Camera: Natus RetCam Envision (130° FOV); wide-field fundus photograph of an infant.
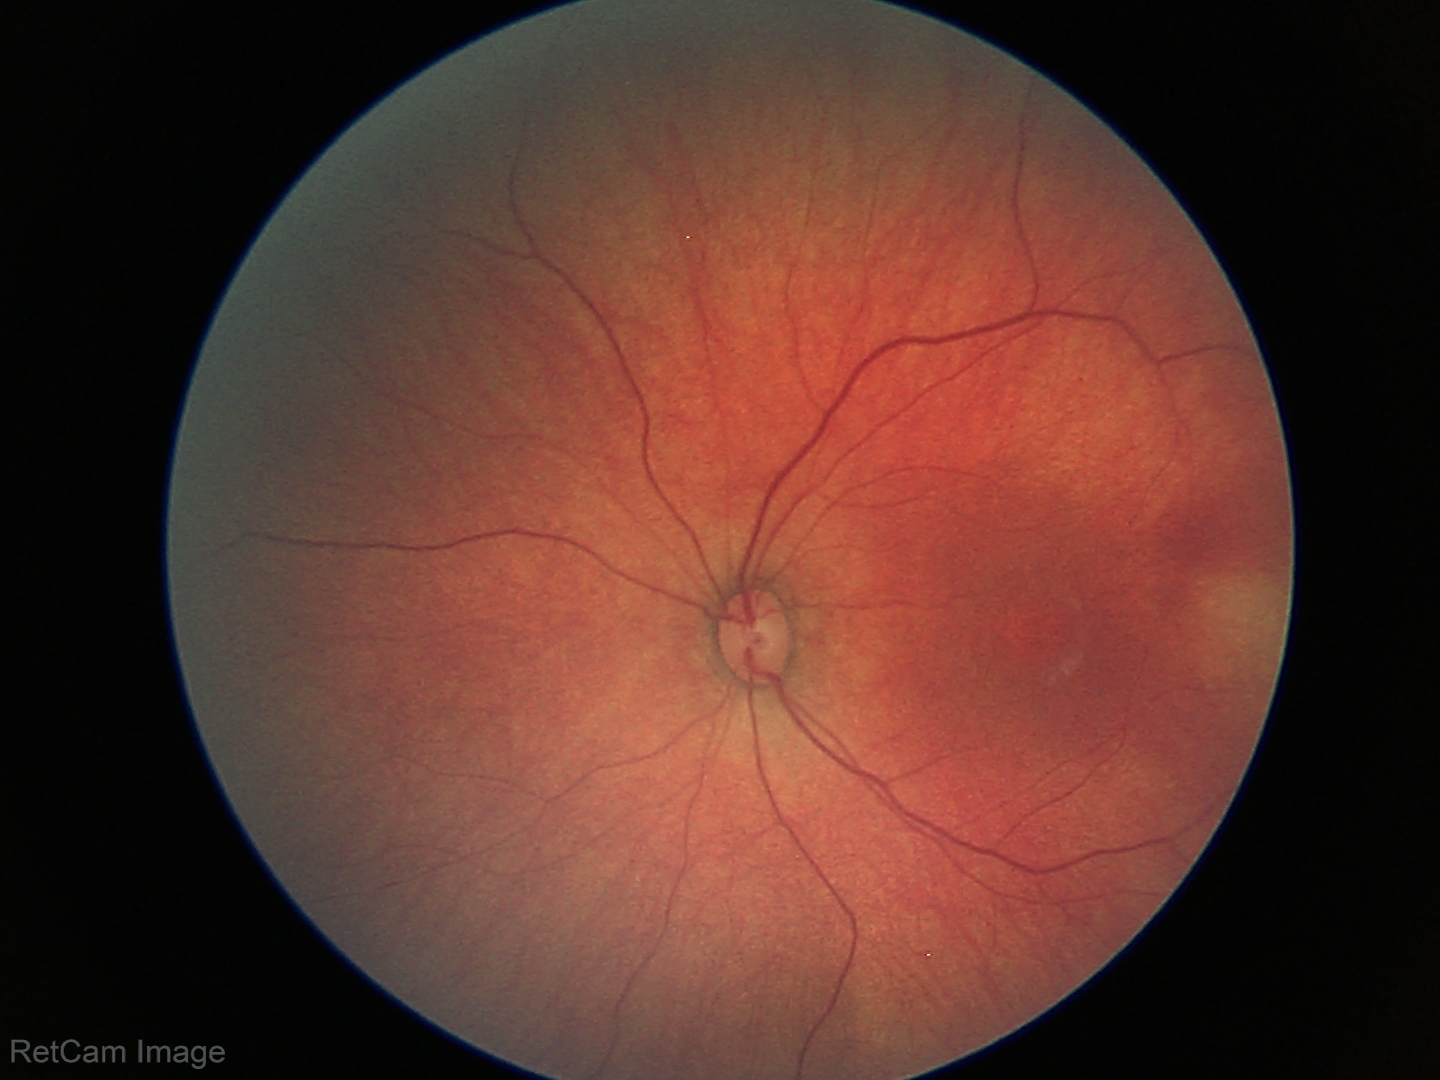 Screening examination with no abnormal retinal findings.